Wide-field fundus image from infant ROP screening
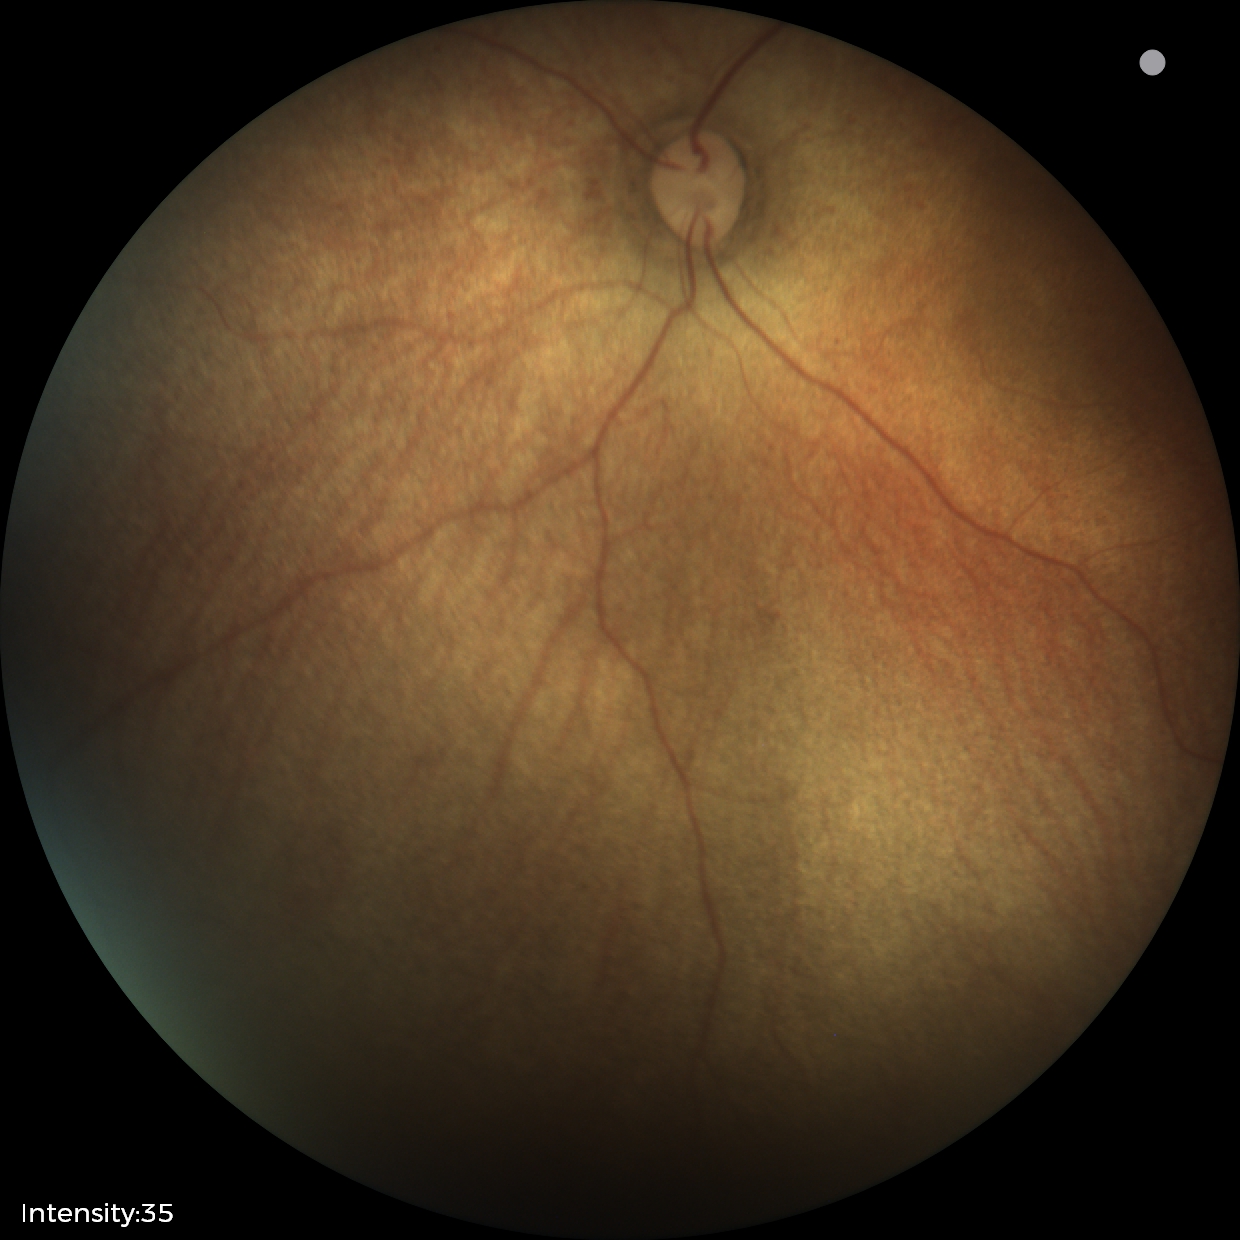
Assessment = normal retinal appearance